Wide-field fundus image from infant ROP screening — 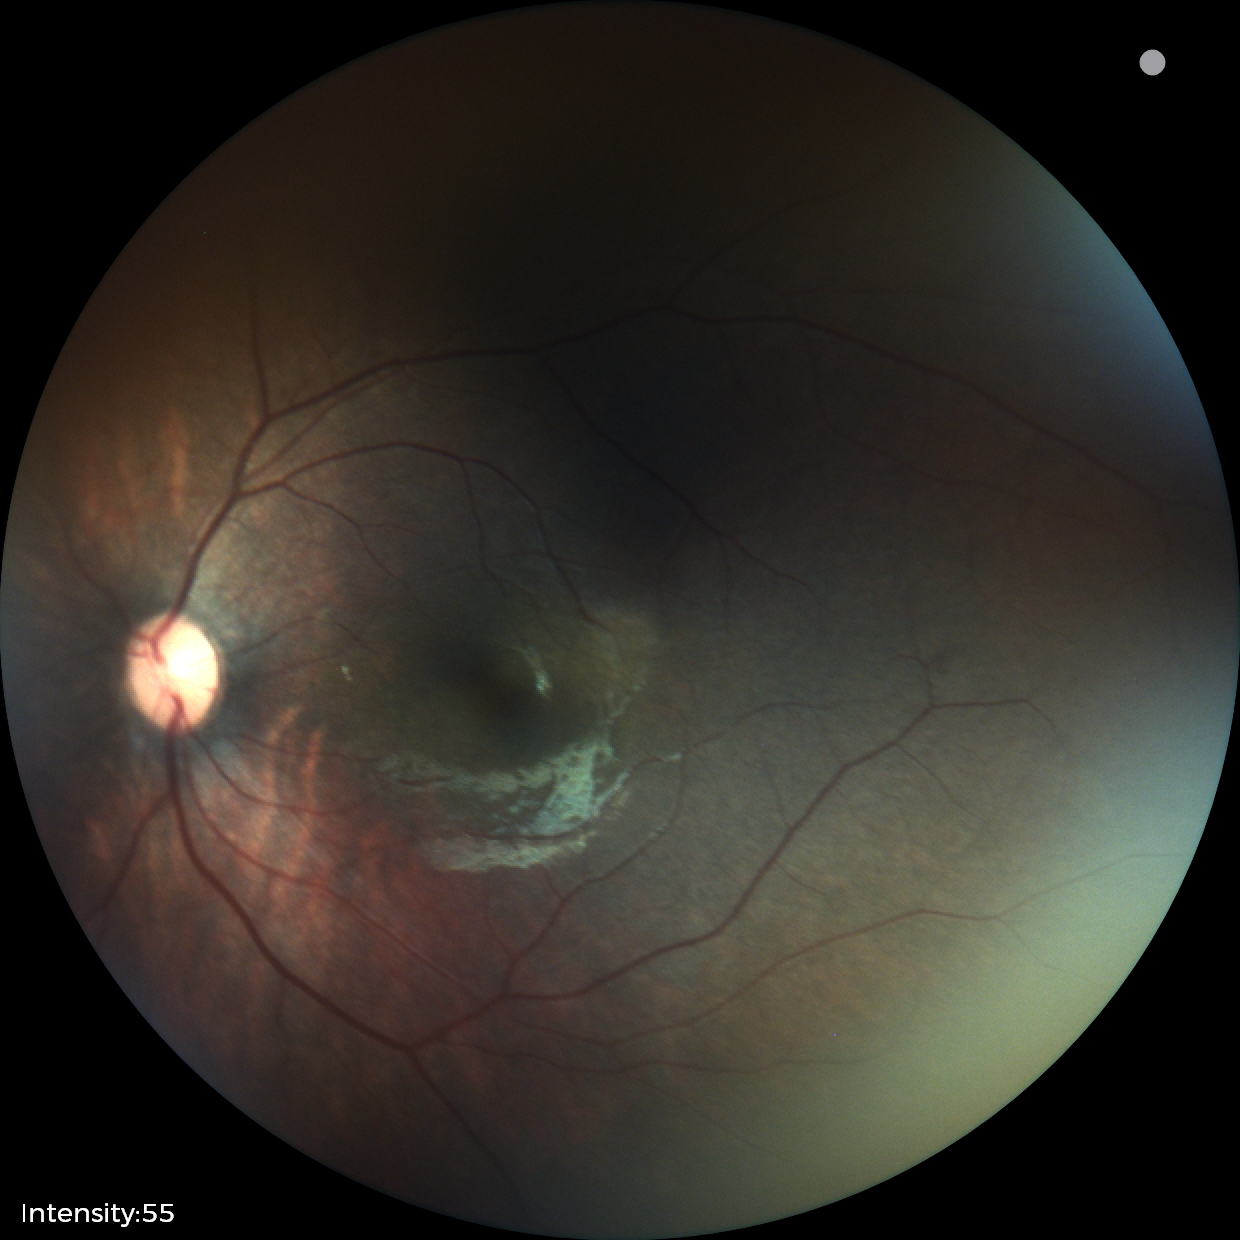
Q: What is the diagnosis from this examination?
A: normal retinal appearance